2086x1764 · FOV: 45 degrees · color fundus image — 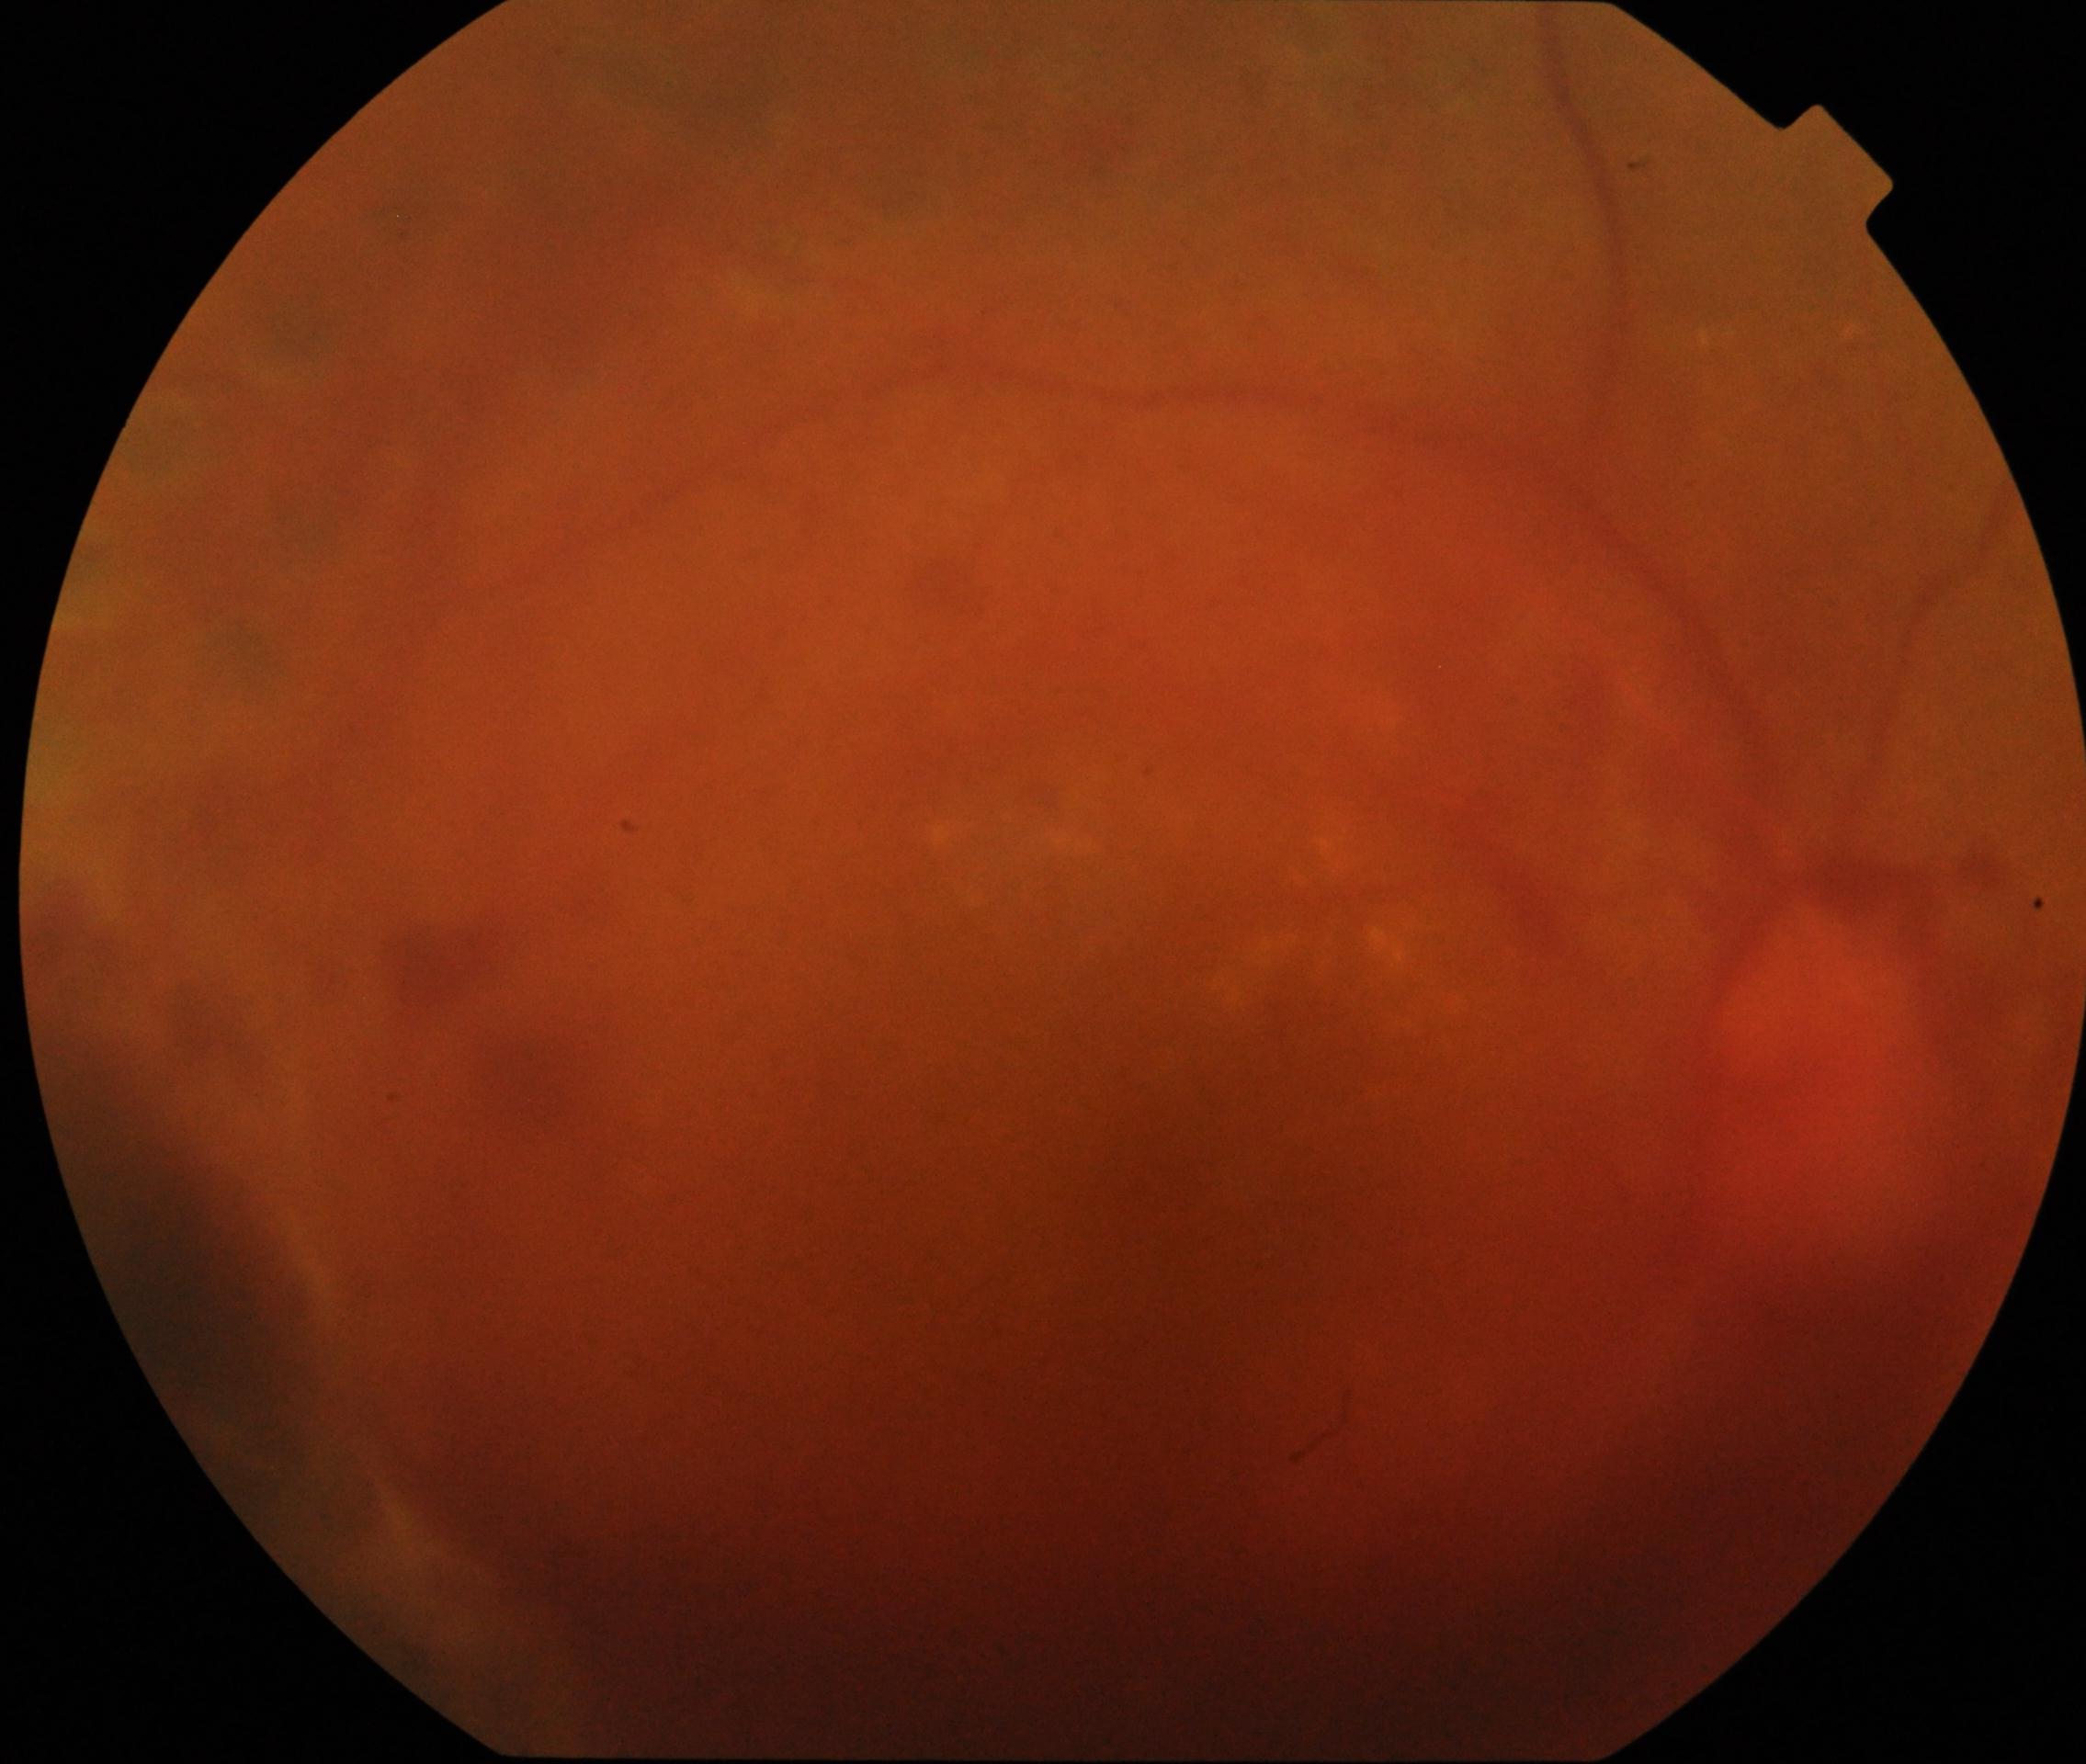 Diabetic retinopathy severity: 4/4 — neovascularization and/or vitreous/pre-retinal hemorrhage.